Color fundus photograph. 45-degree field of view. 1932x1916px.
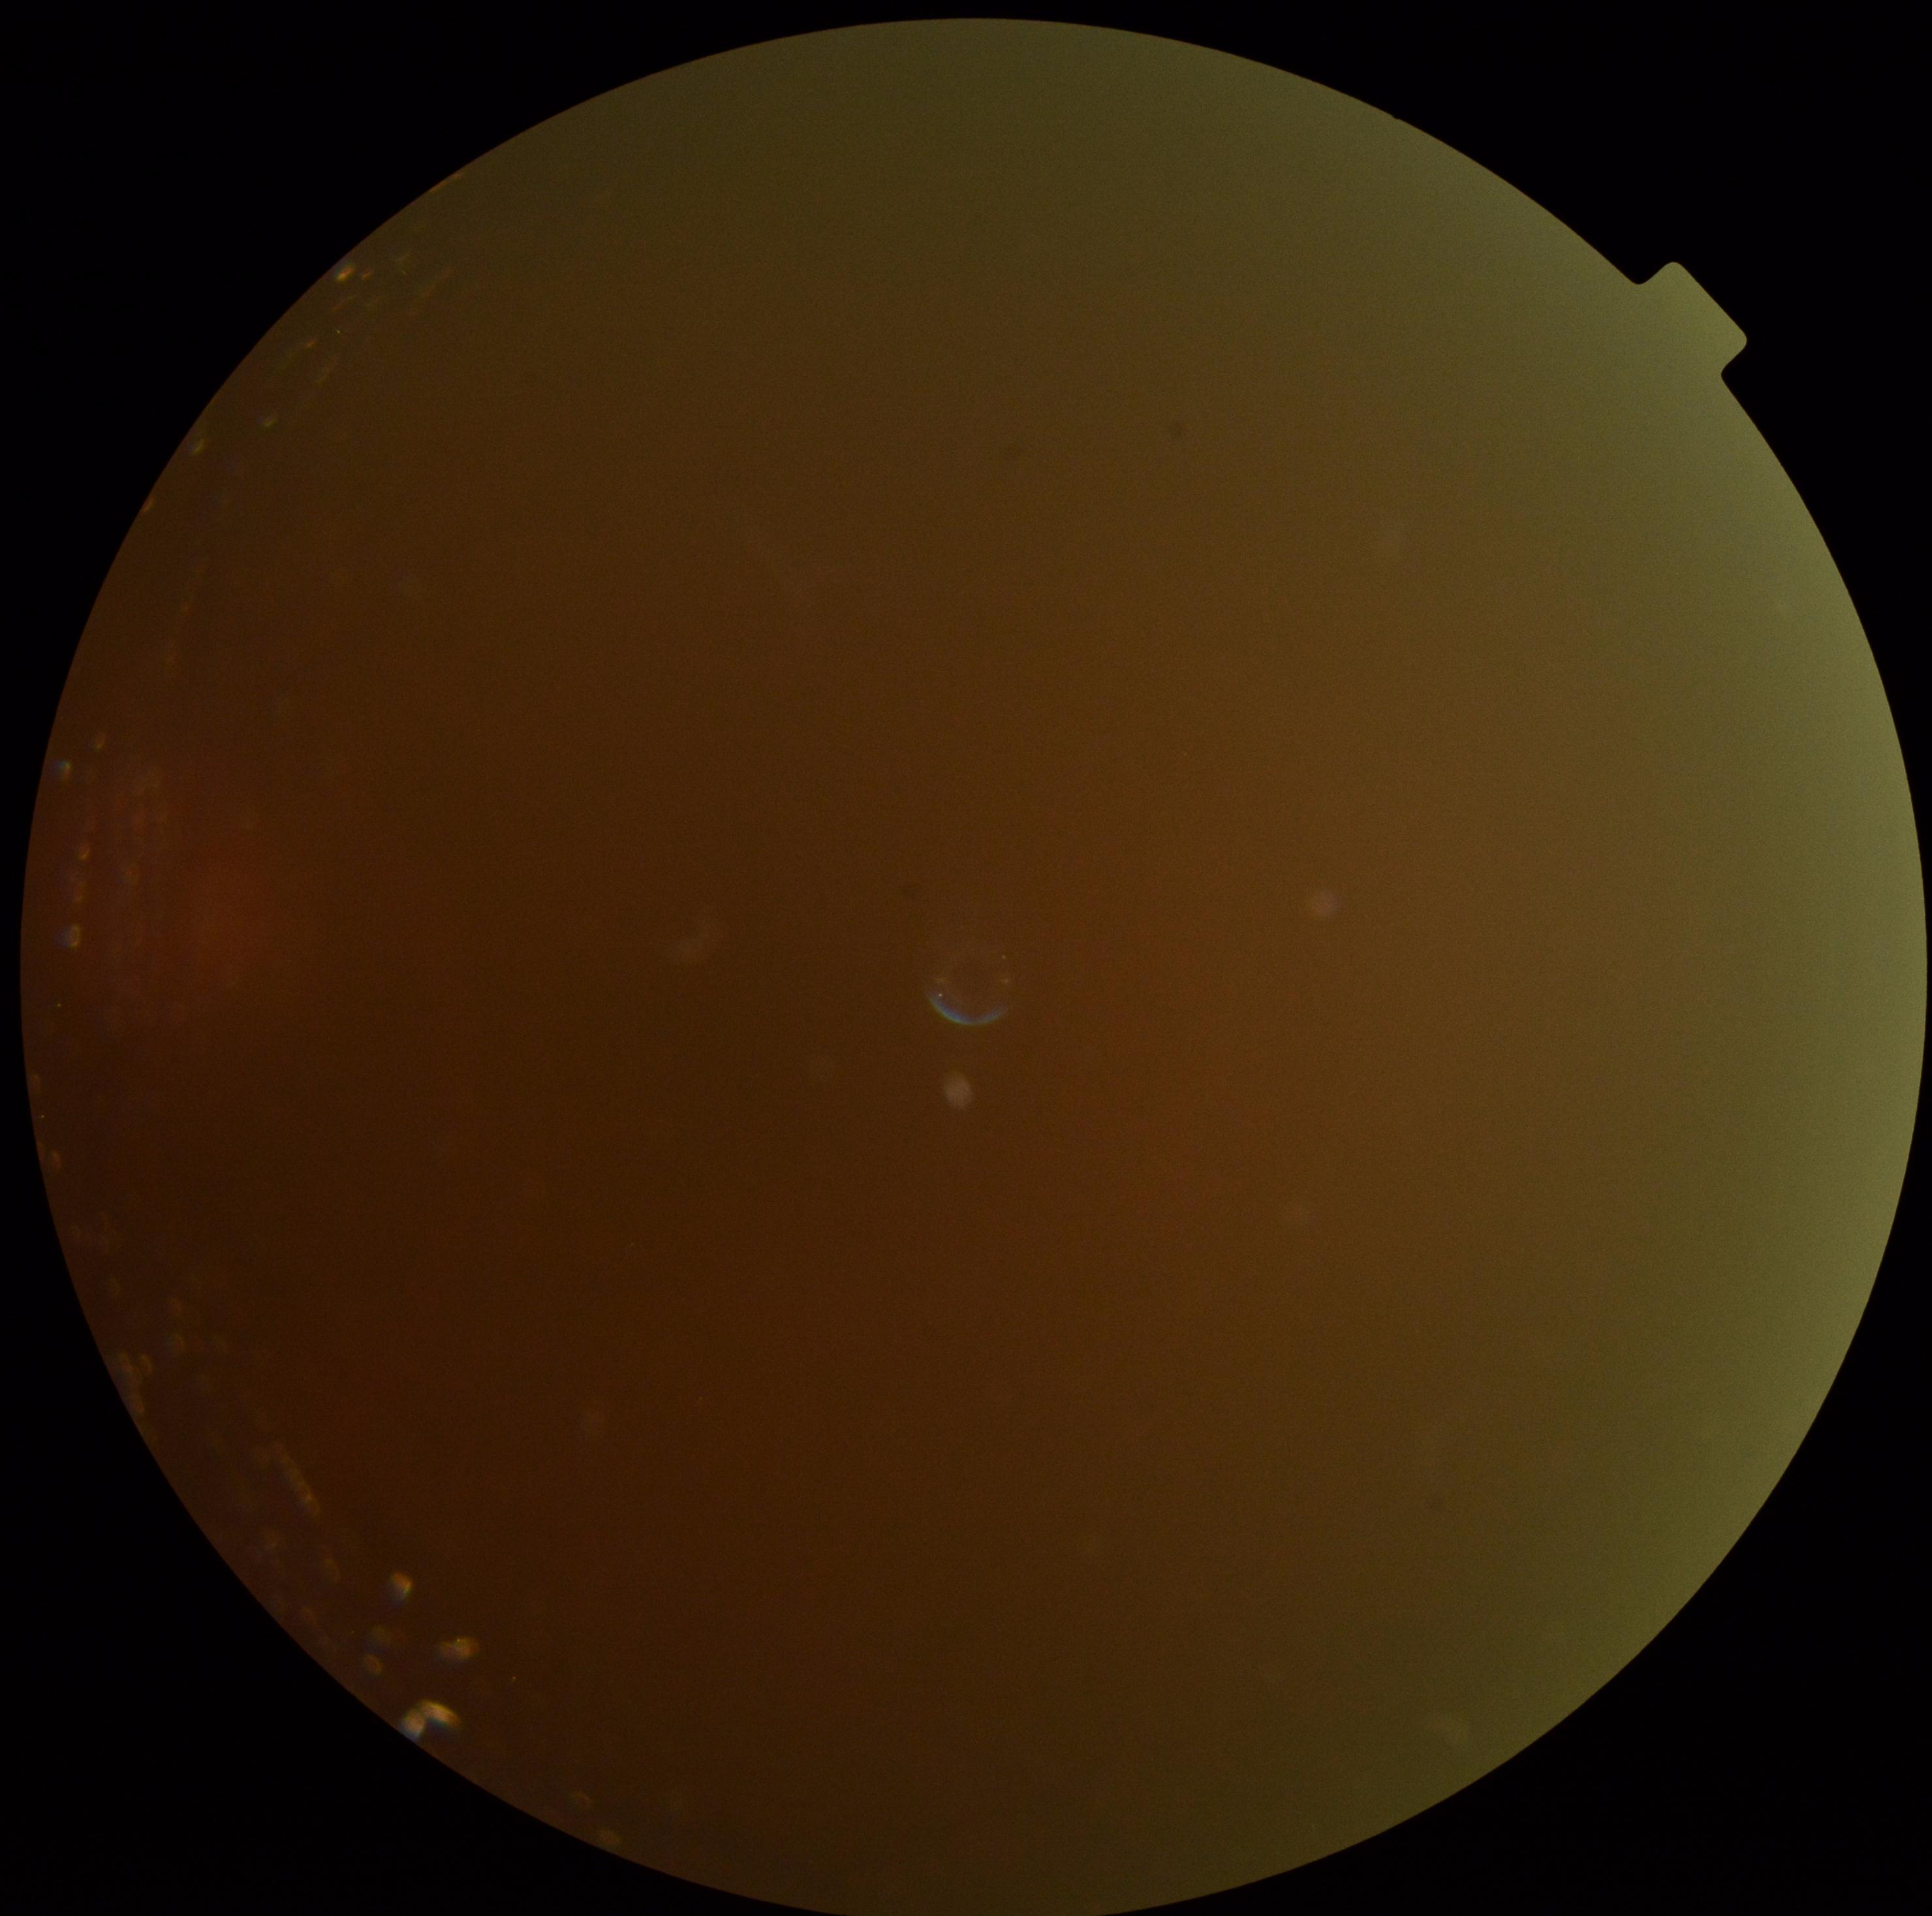
Findings:
• DR: ungradable